Color fundus image: 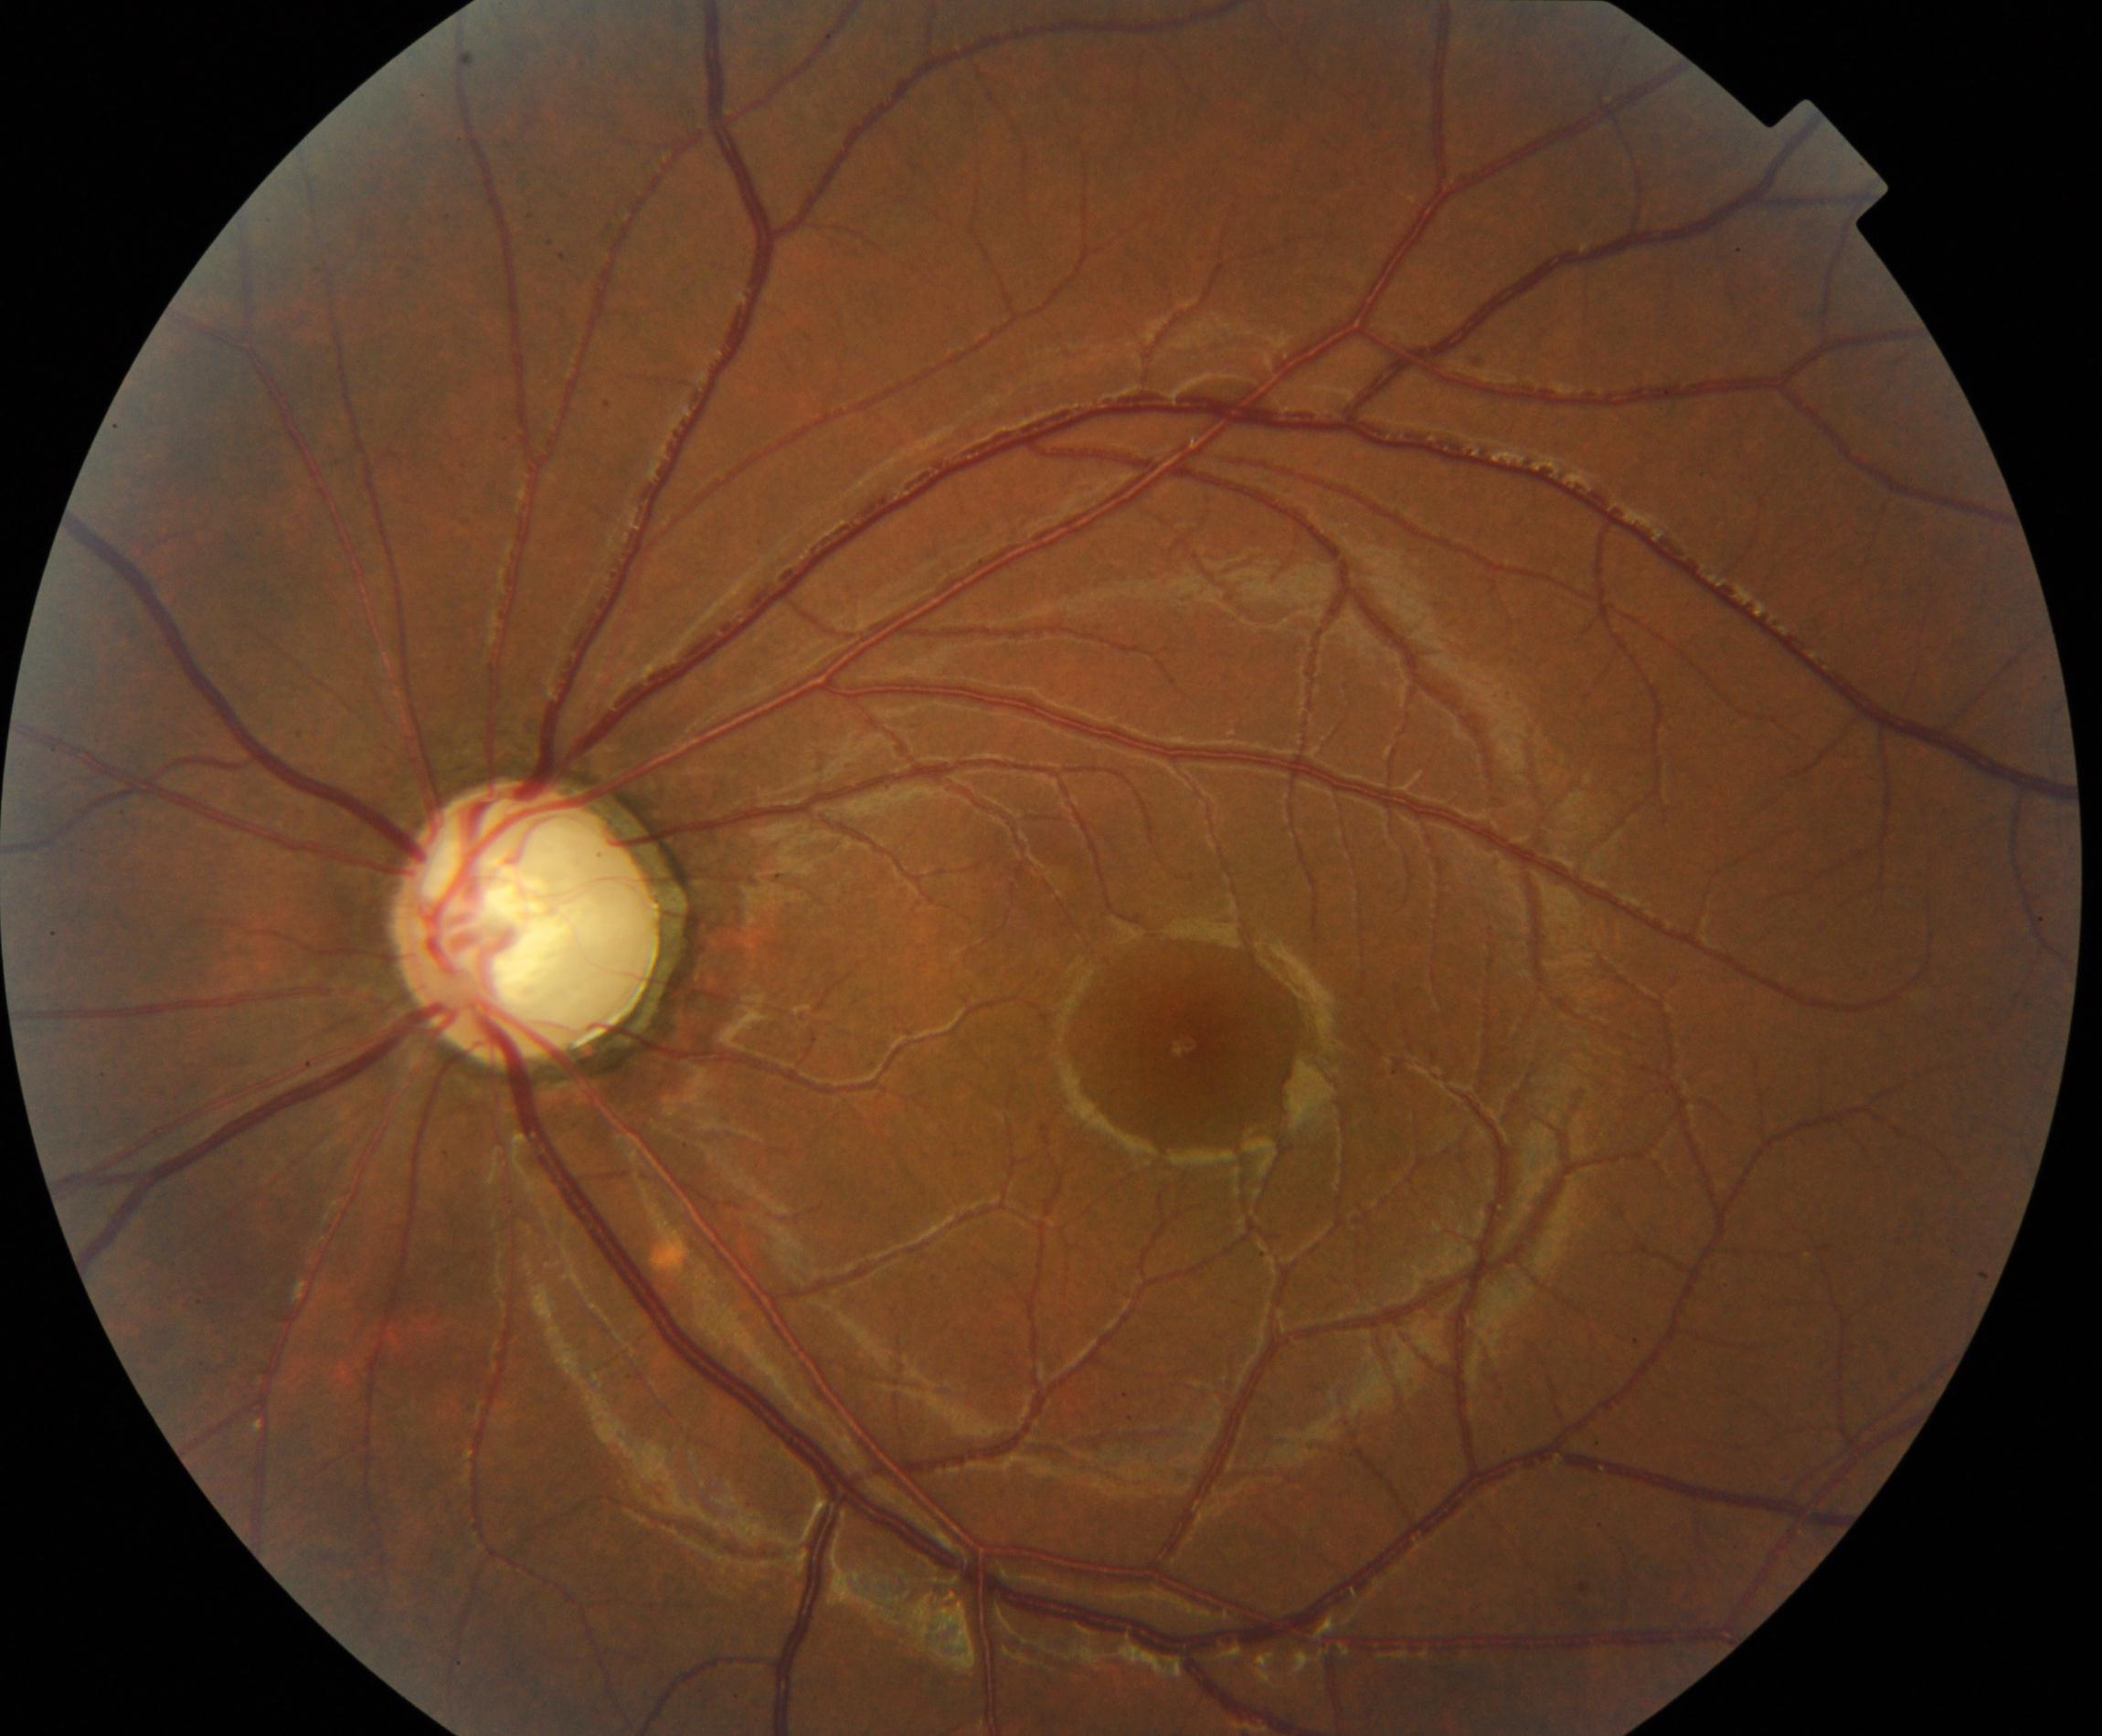 Diagnosis: possible glaucoma.